640x480px. Pediatric wide-field fundus photograph: 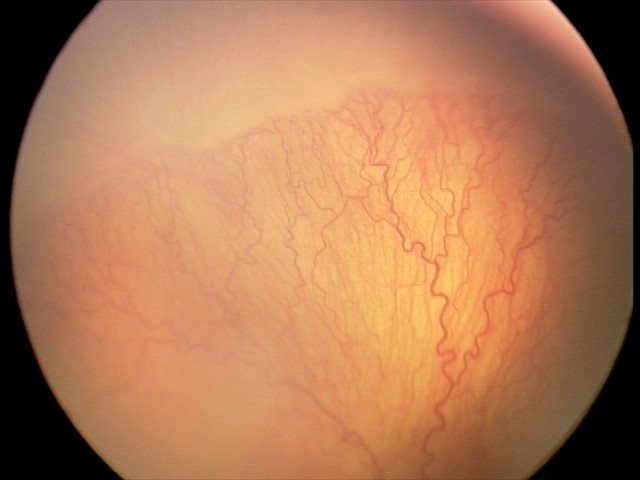 From an examination with diagnosis of aggressive retinopathy of prematurity.